Wide-field contact fundus photograph of an infant: 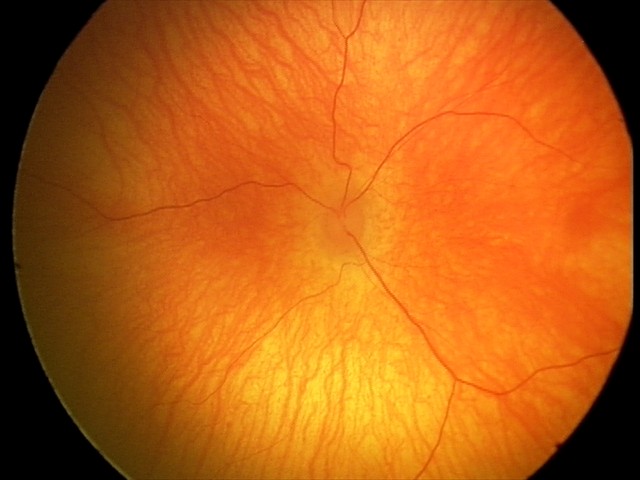

Physiological retinal appearance for postconceptual age.